45-degree field of view — 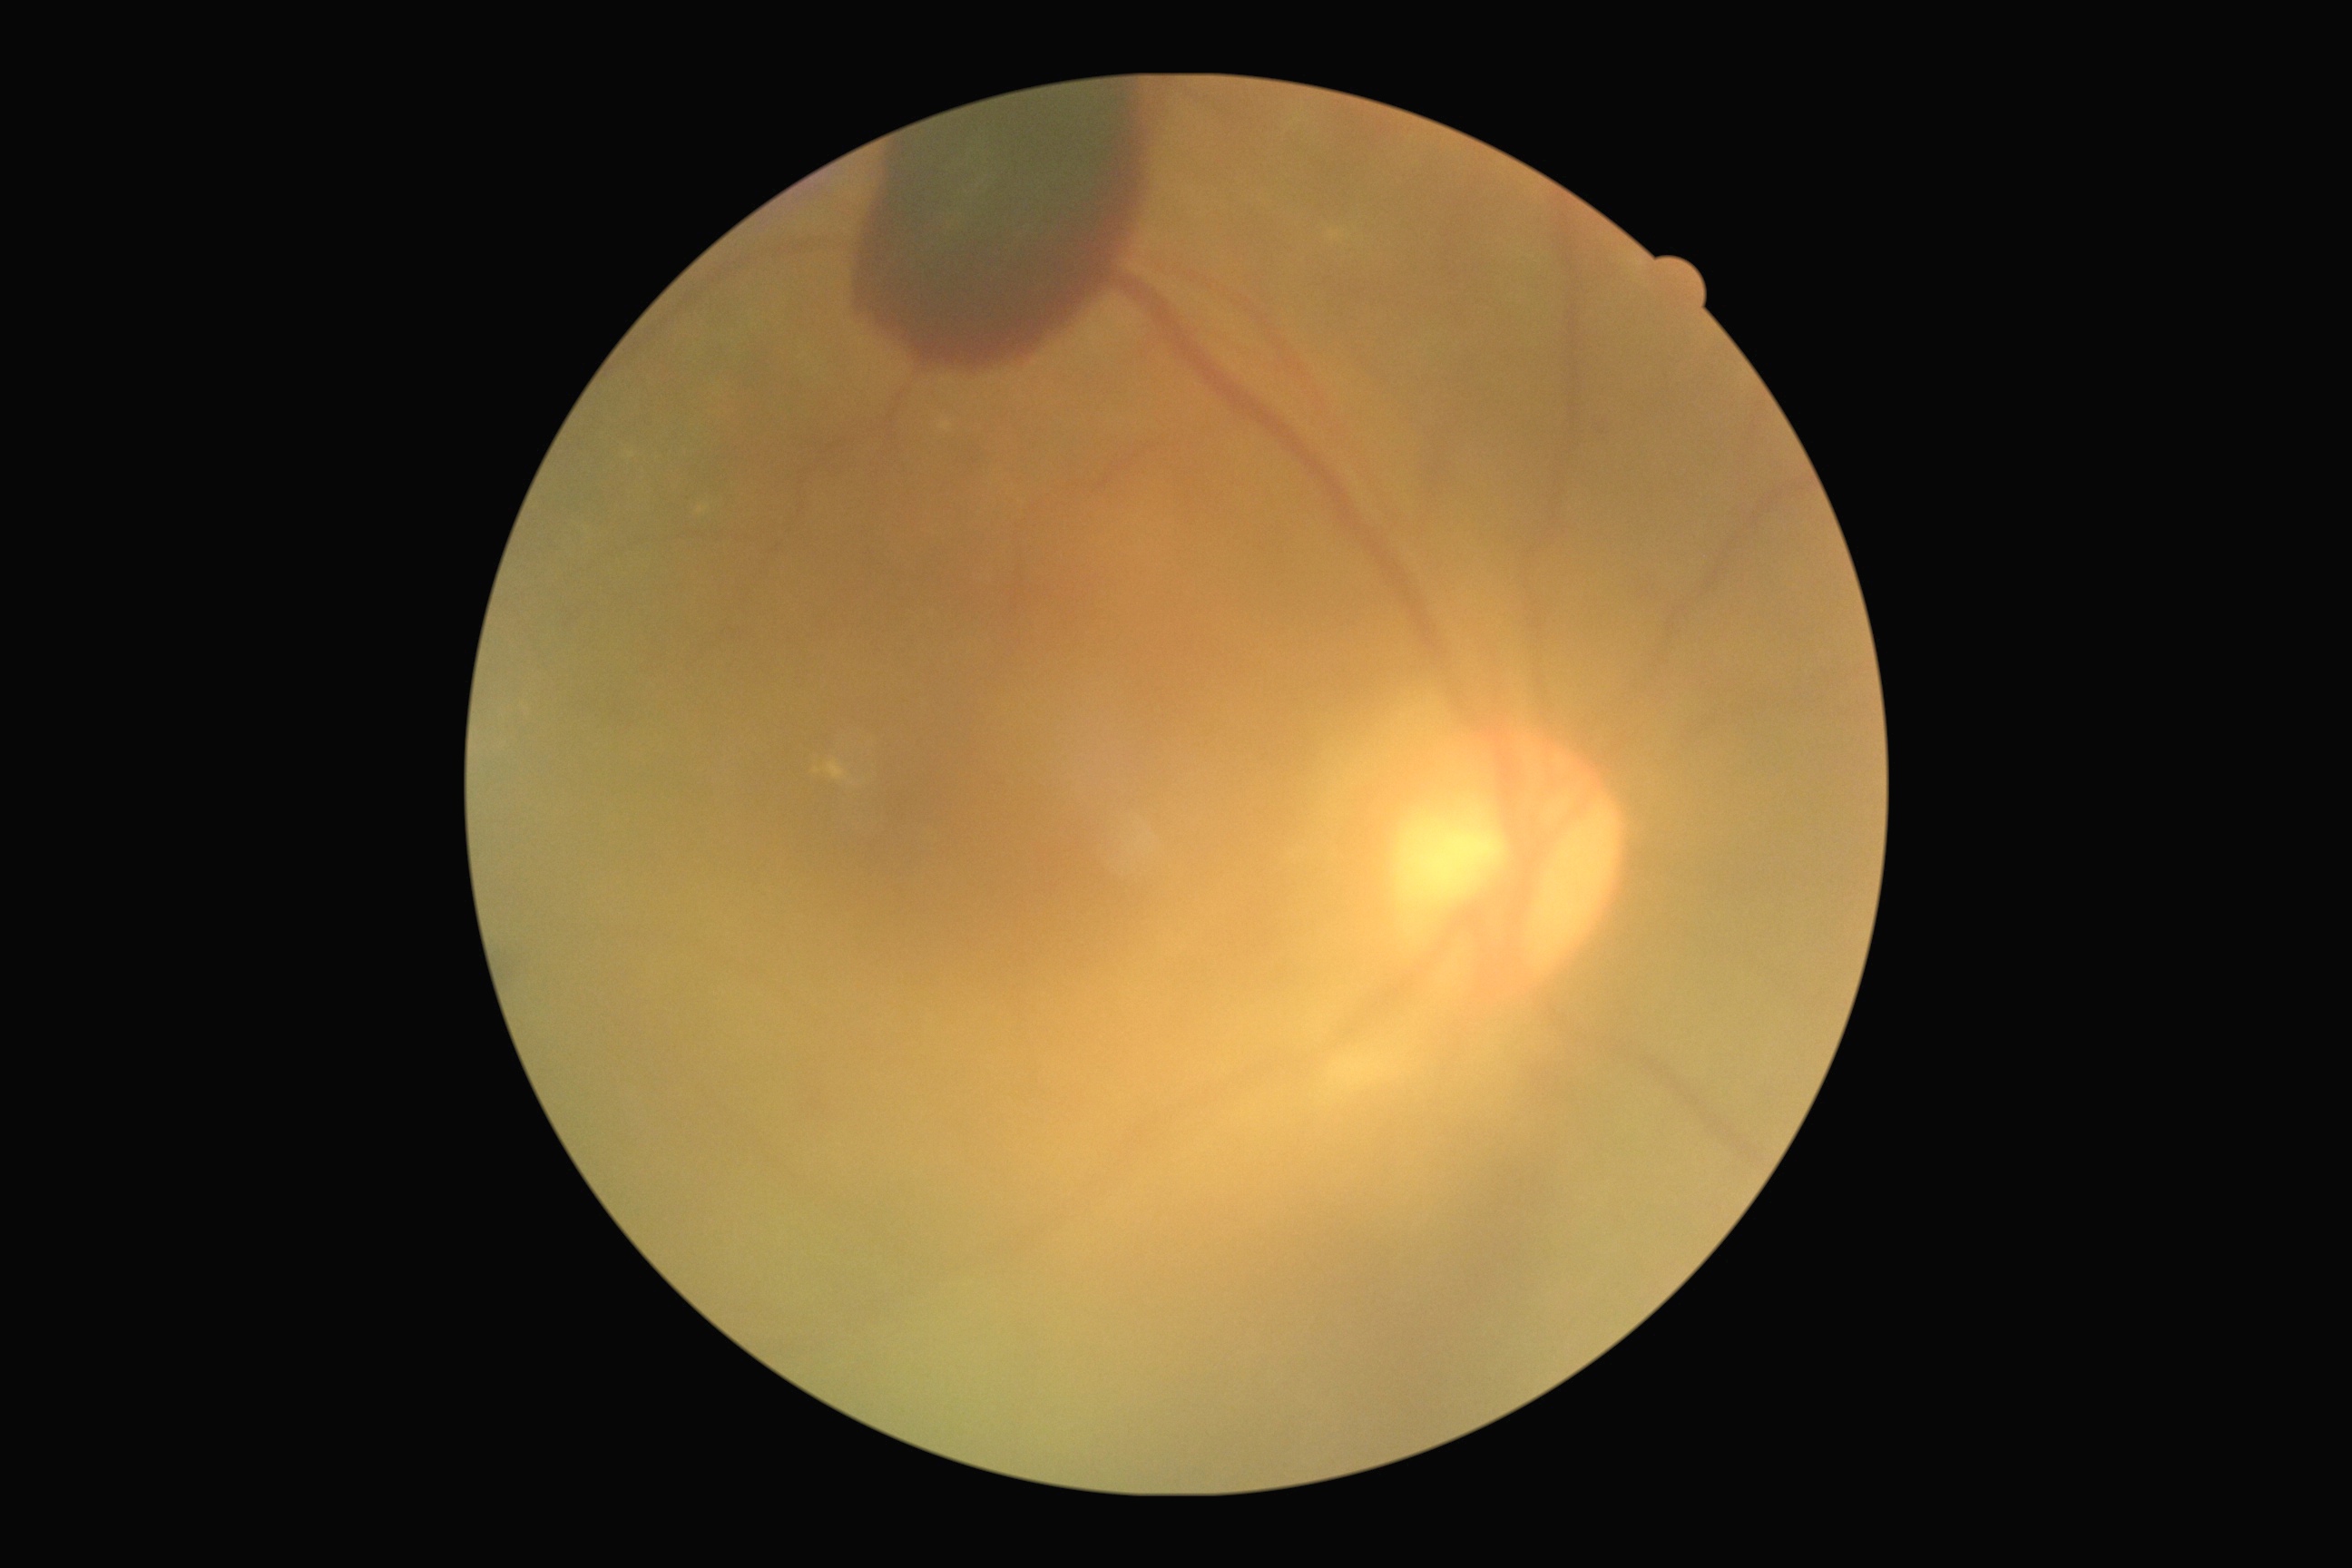
The retinopathy is classified as proliferative diabetic retinopathy. DR grade: 4 (PDR).